45° FOV. Color fundus photograph. 2352 by 1568 pixels: 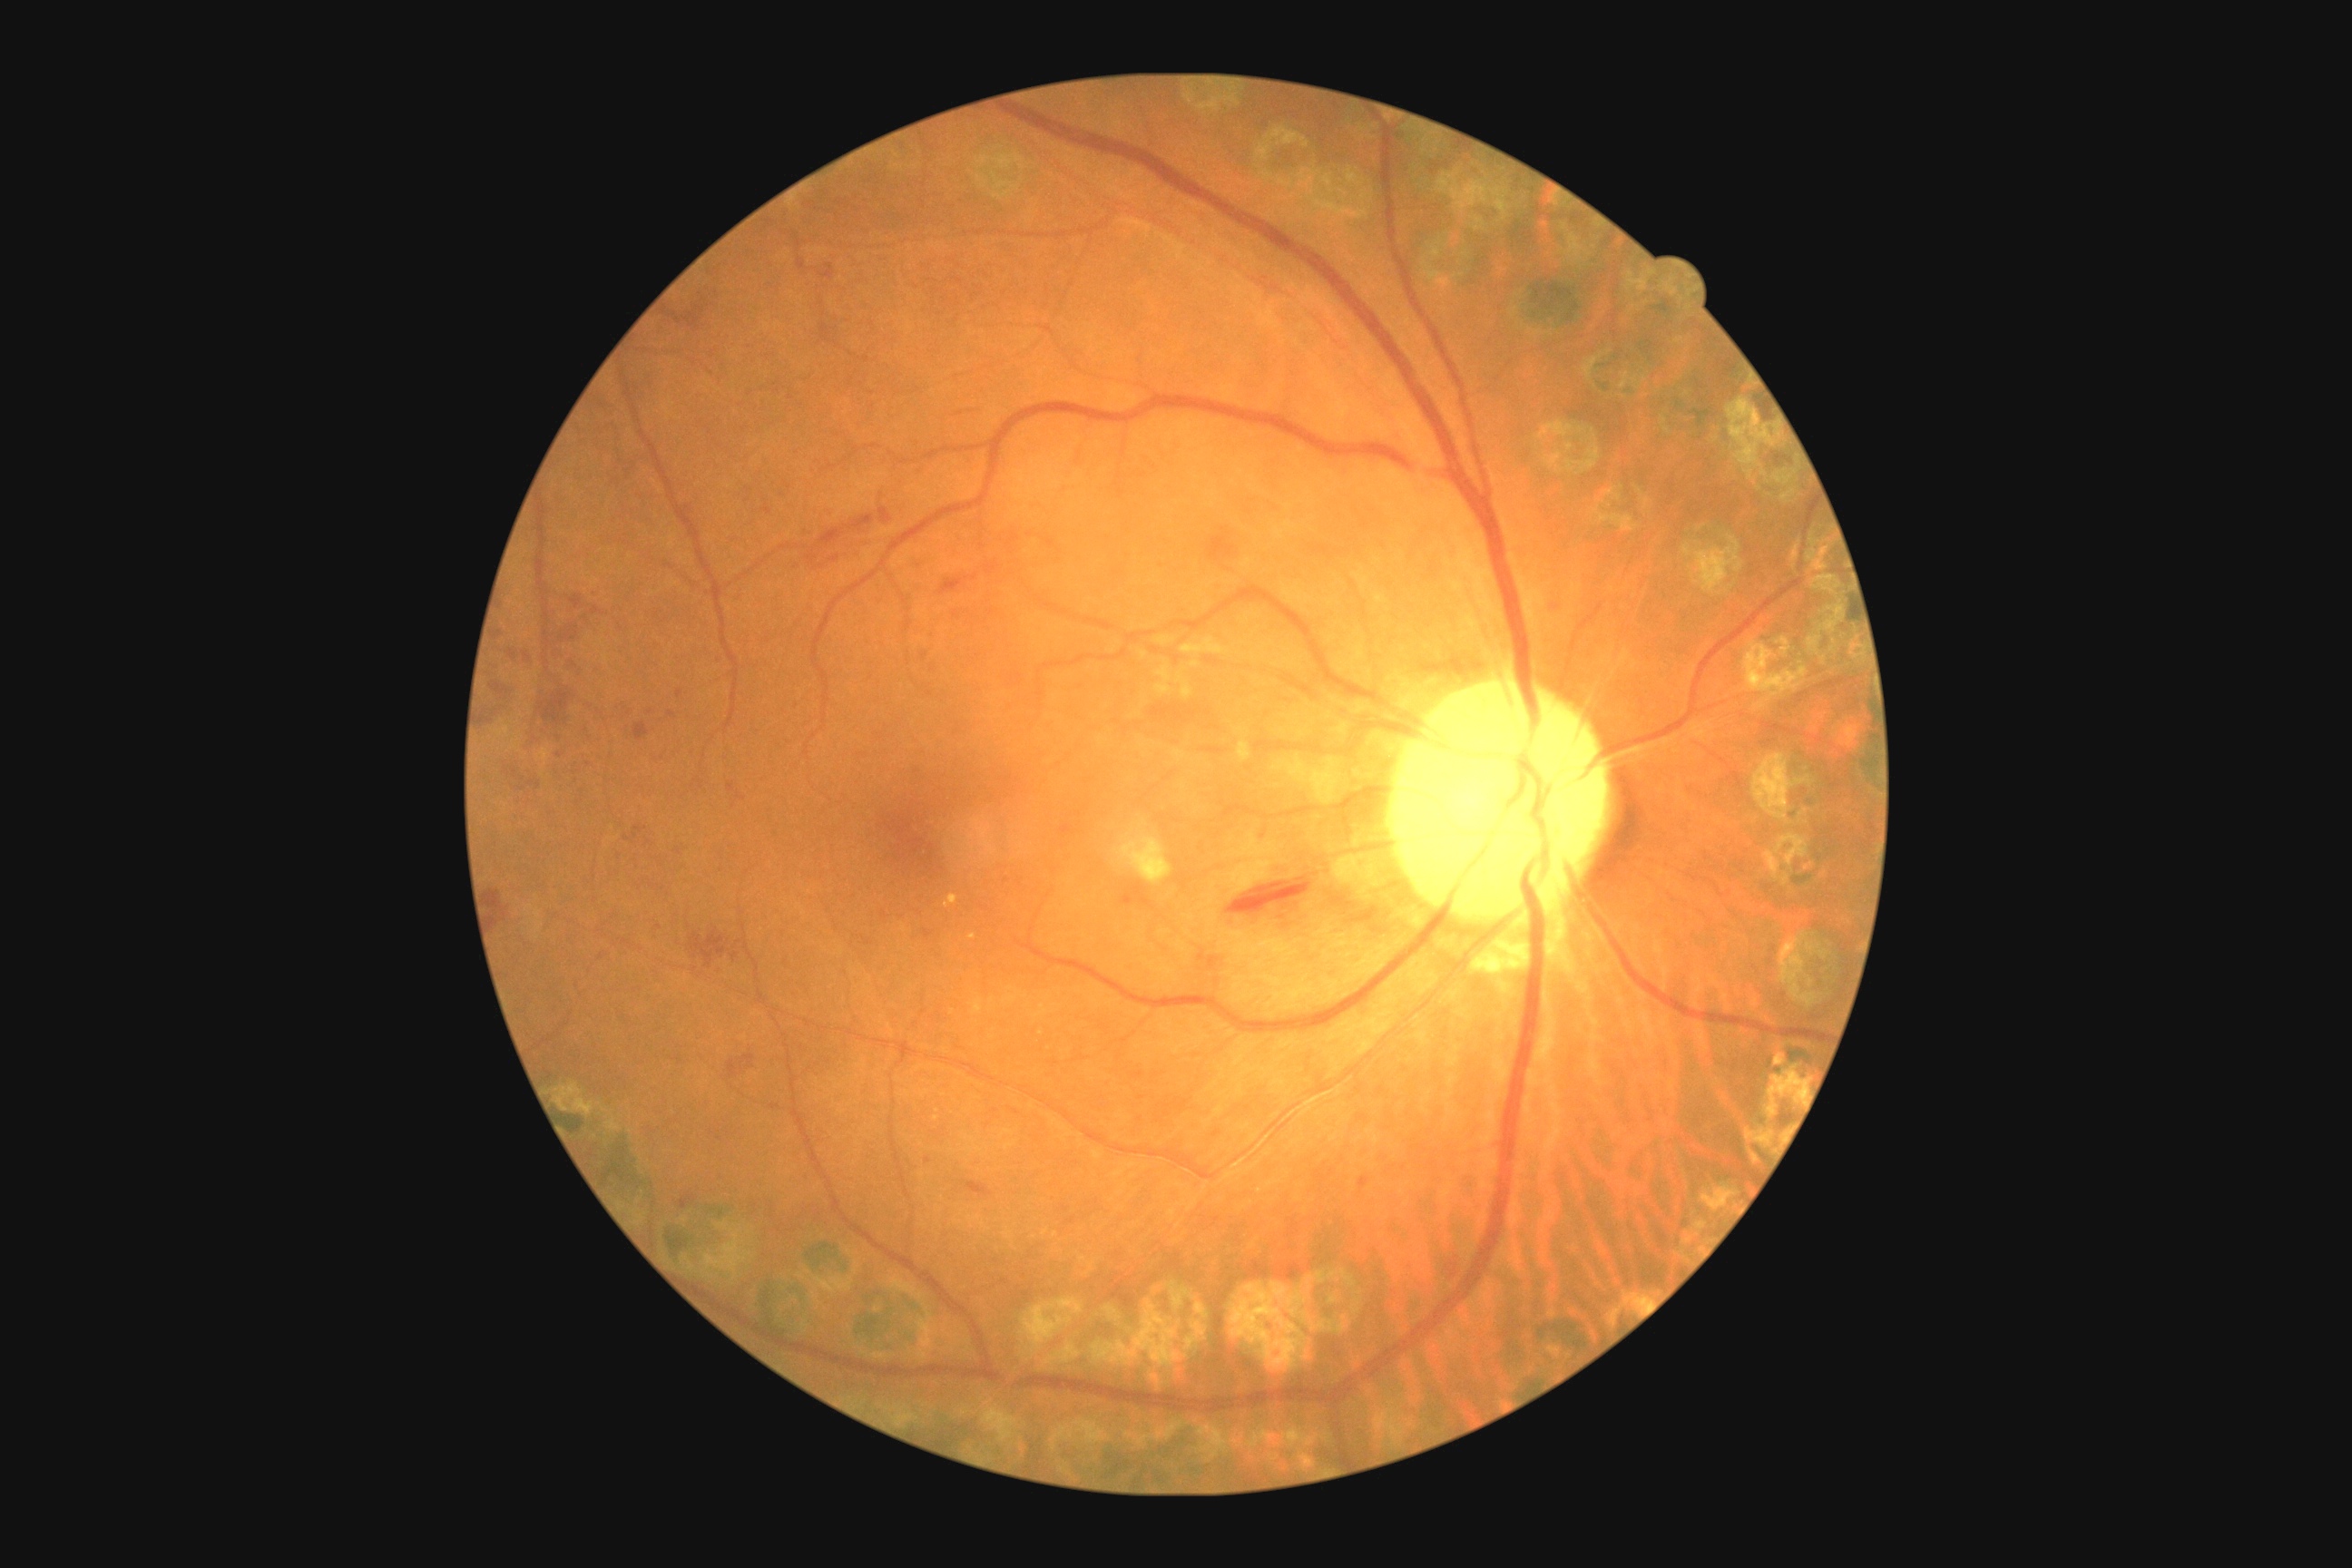 Diabetic retinopathy severity is grade 2 (moderate NPDR) — more than just microaneurysms but less than severe NPDR.